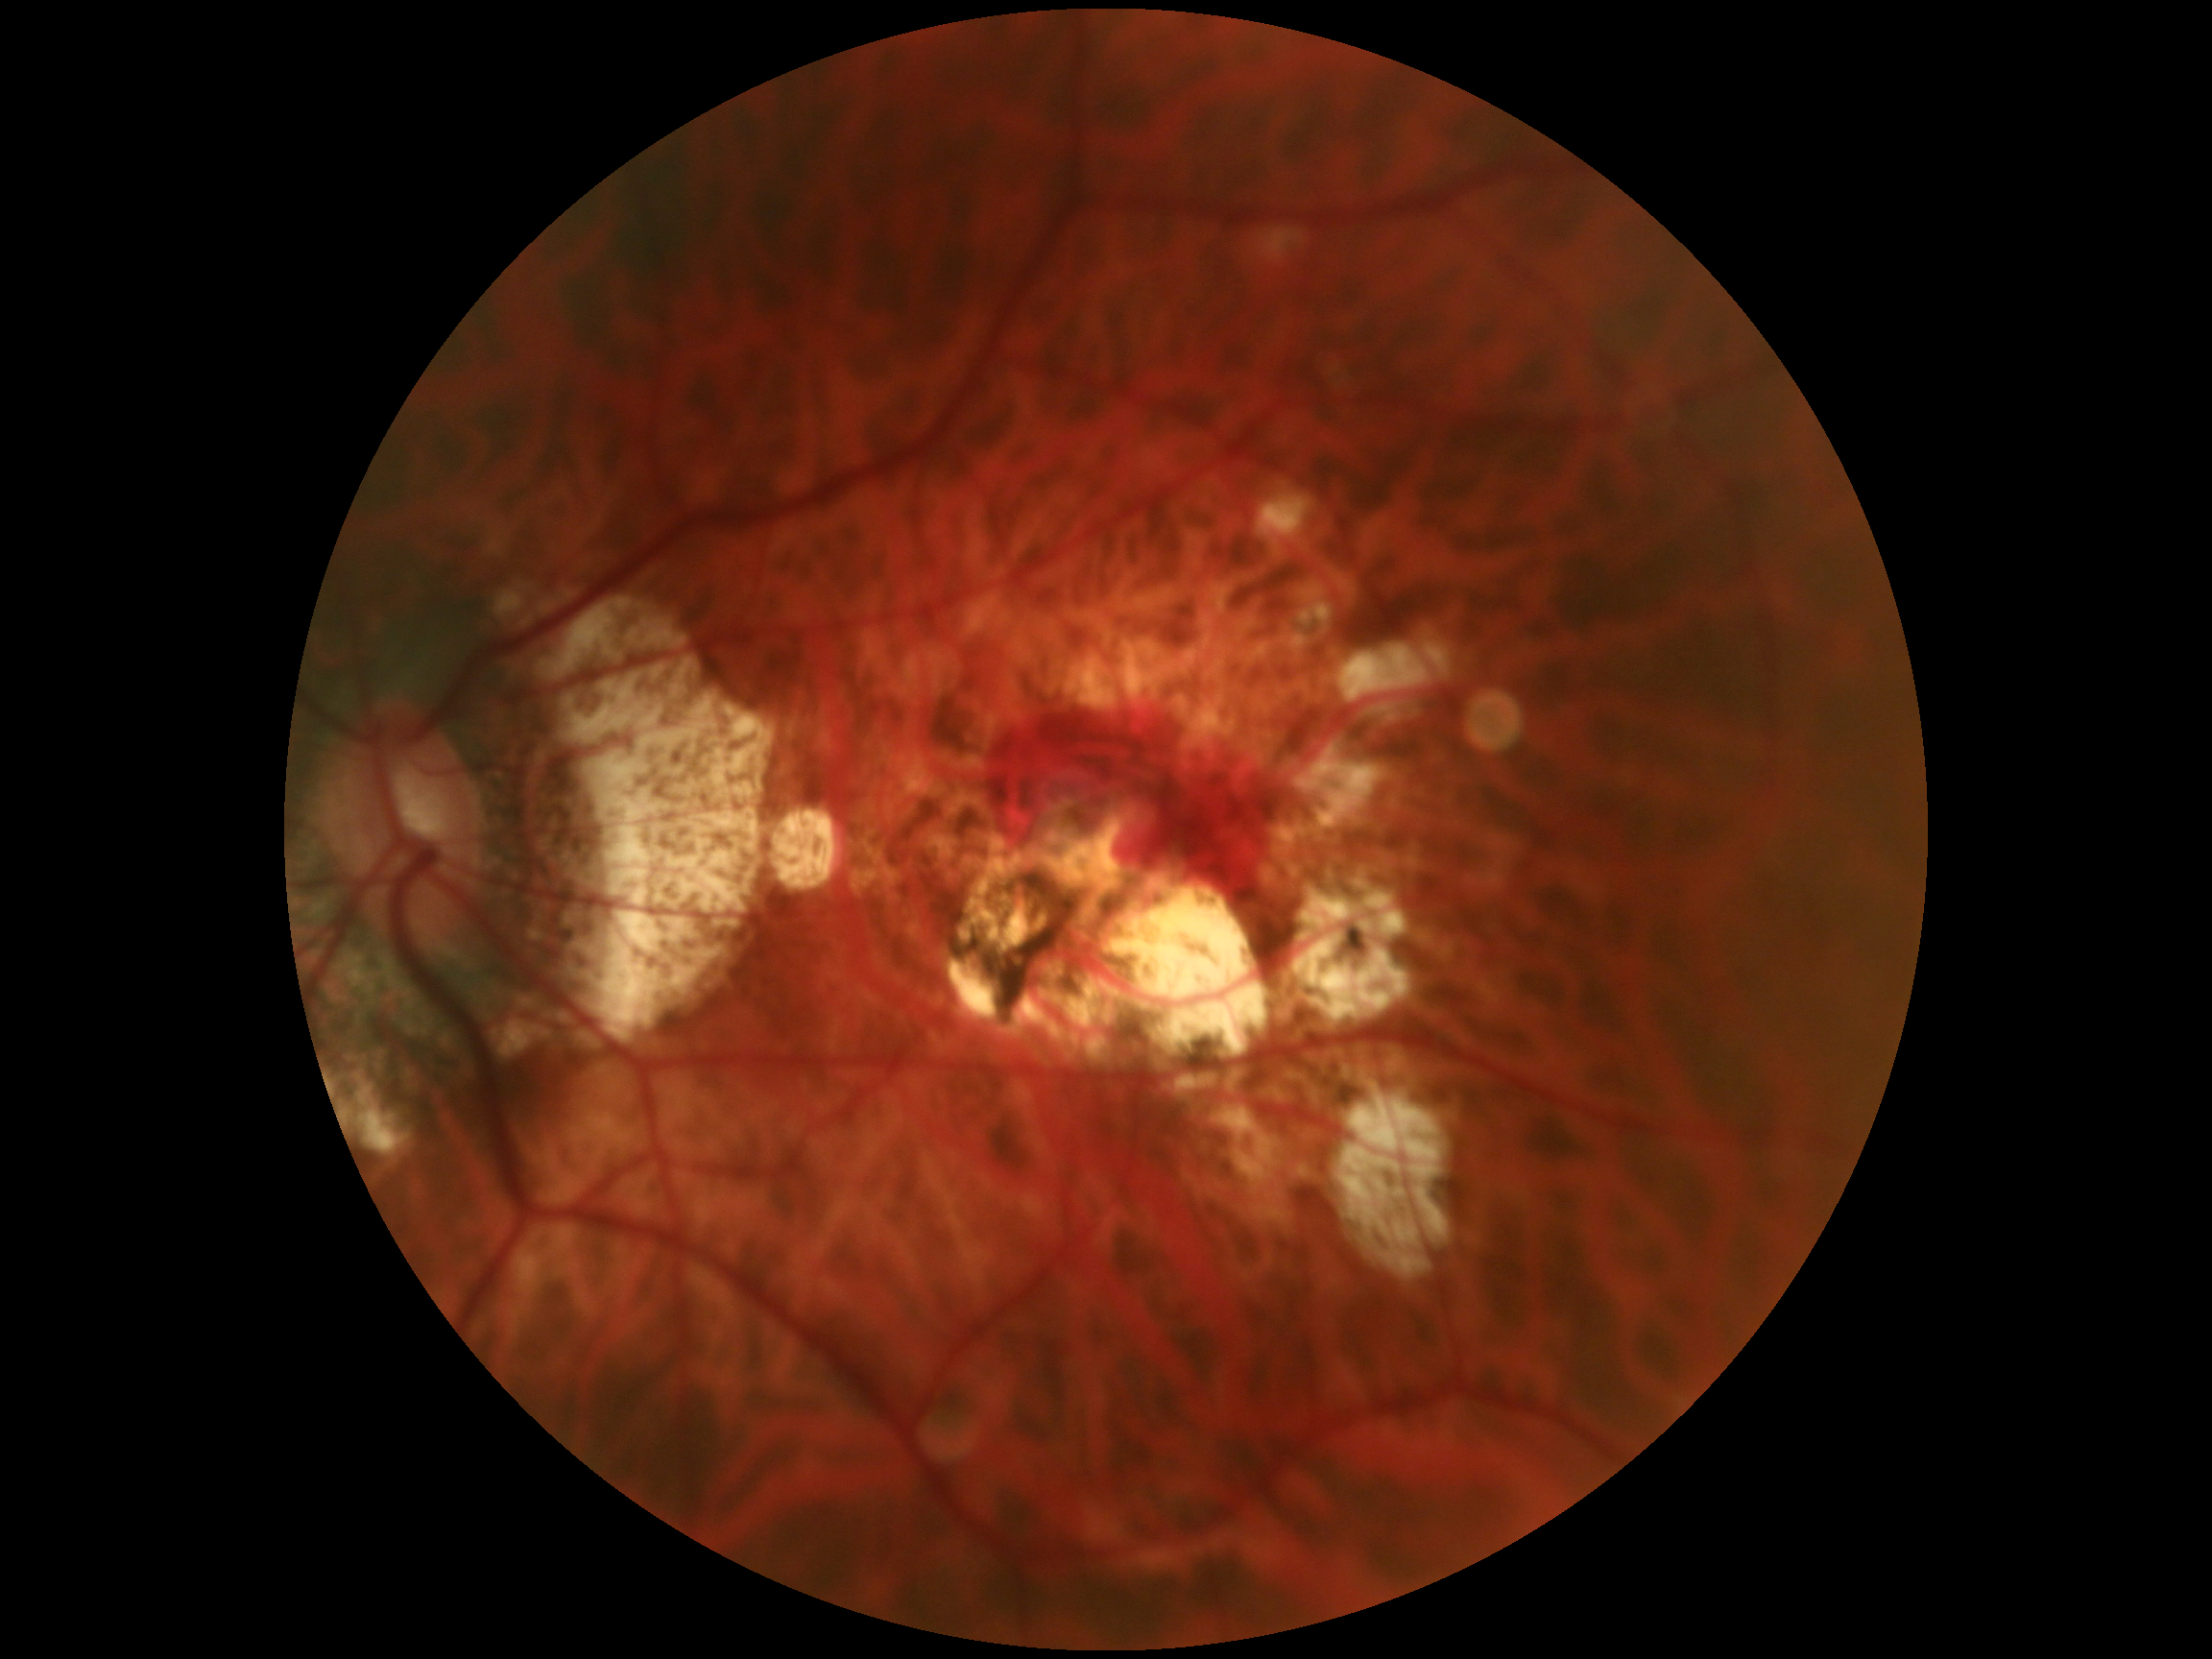
• DR class: proliferative diabetic retinopathy
• diabetic retinopathy (DR): grade 4 (PDR)